Retinal fundus photograph; 50-degree field of view:
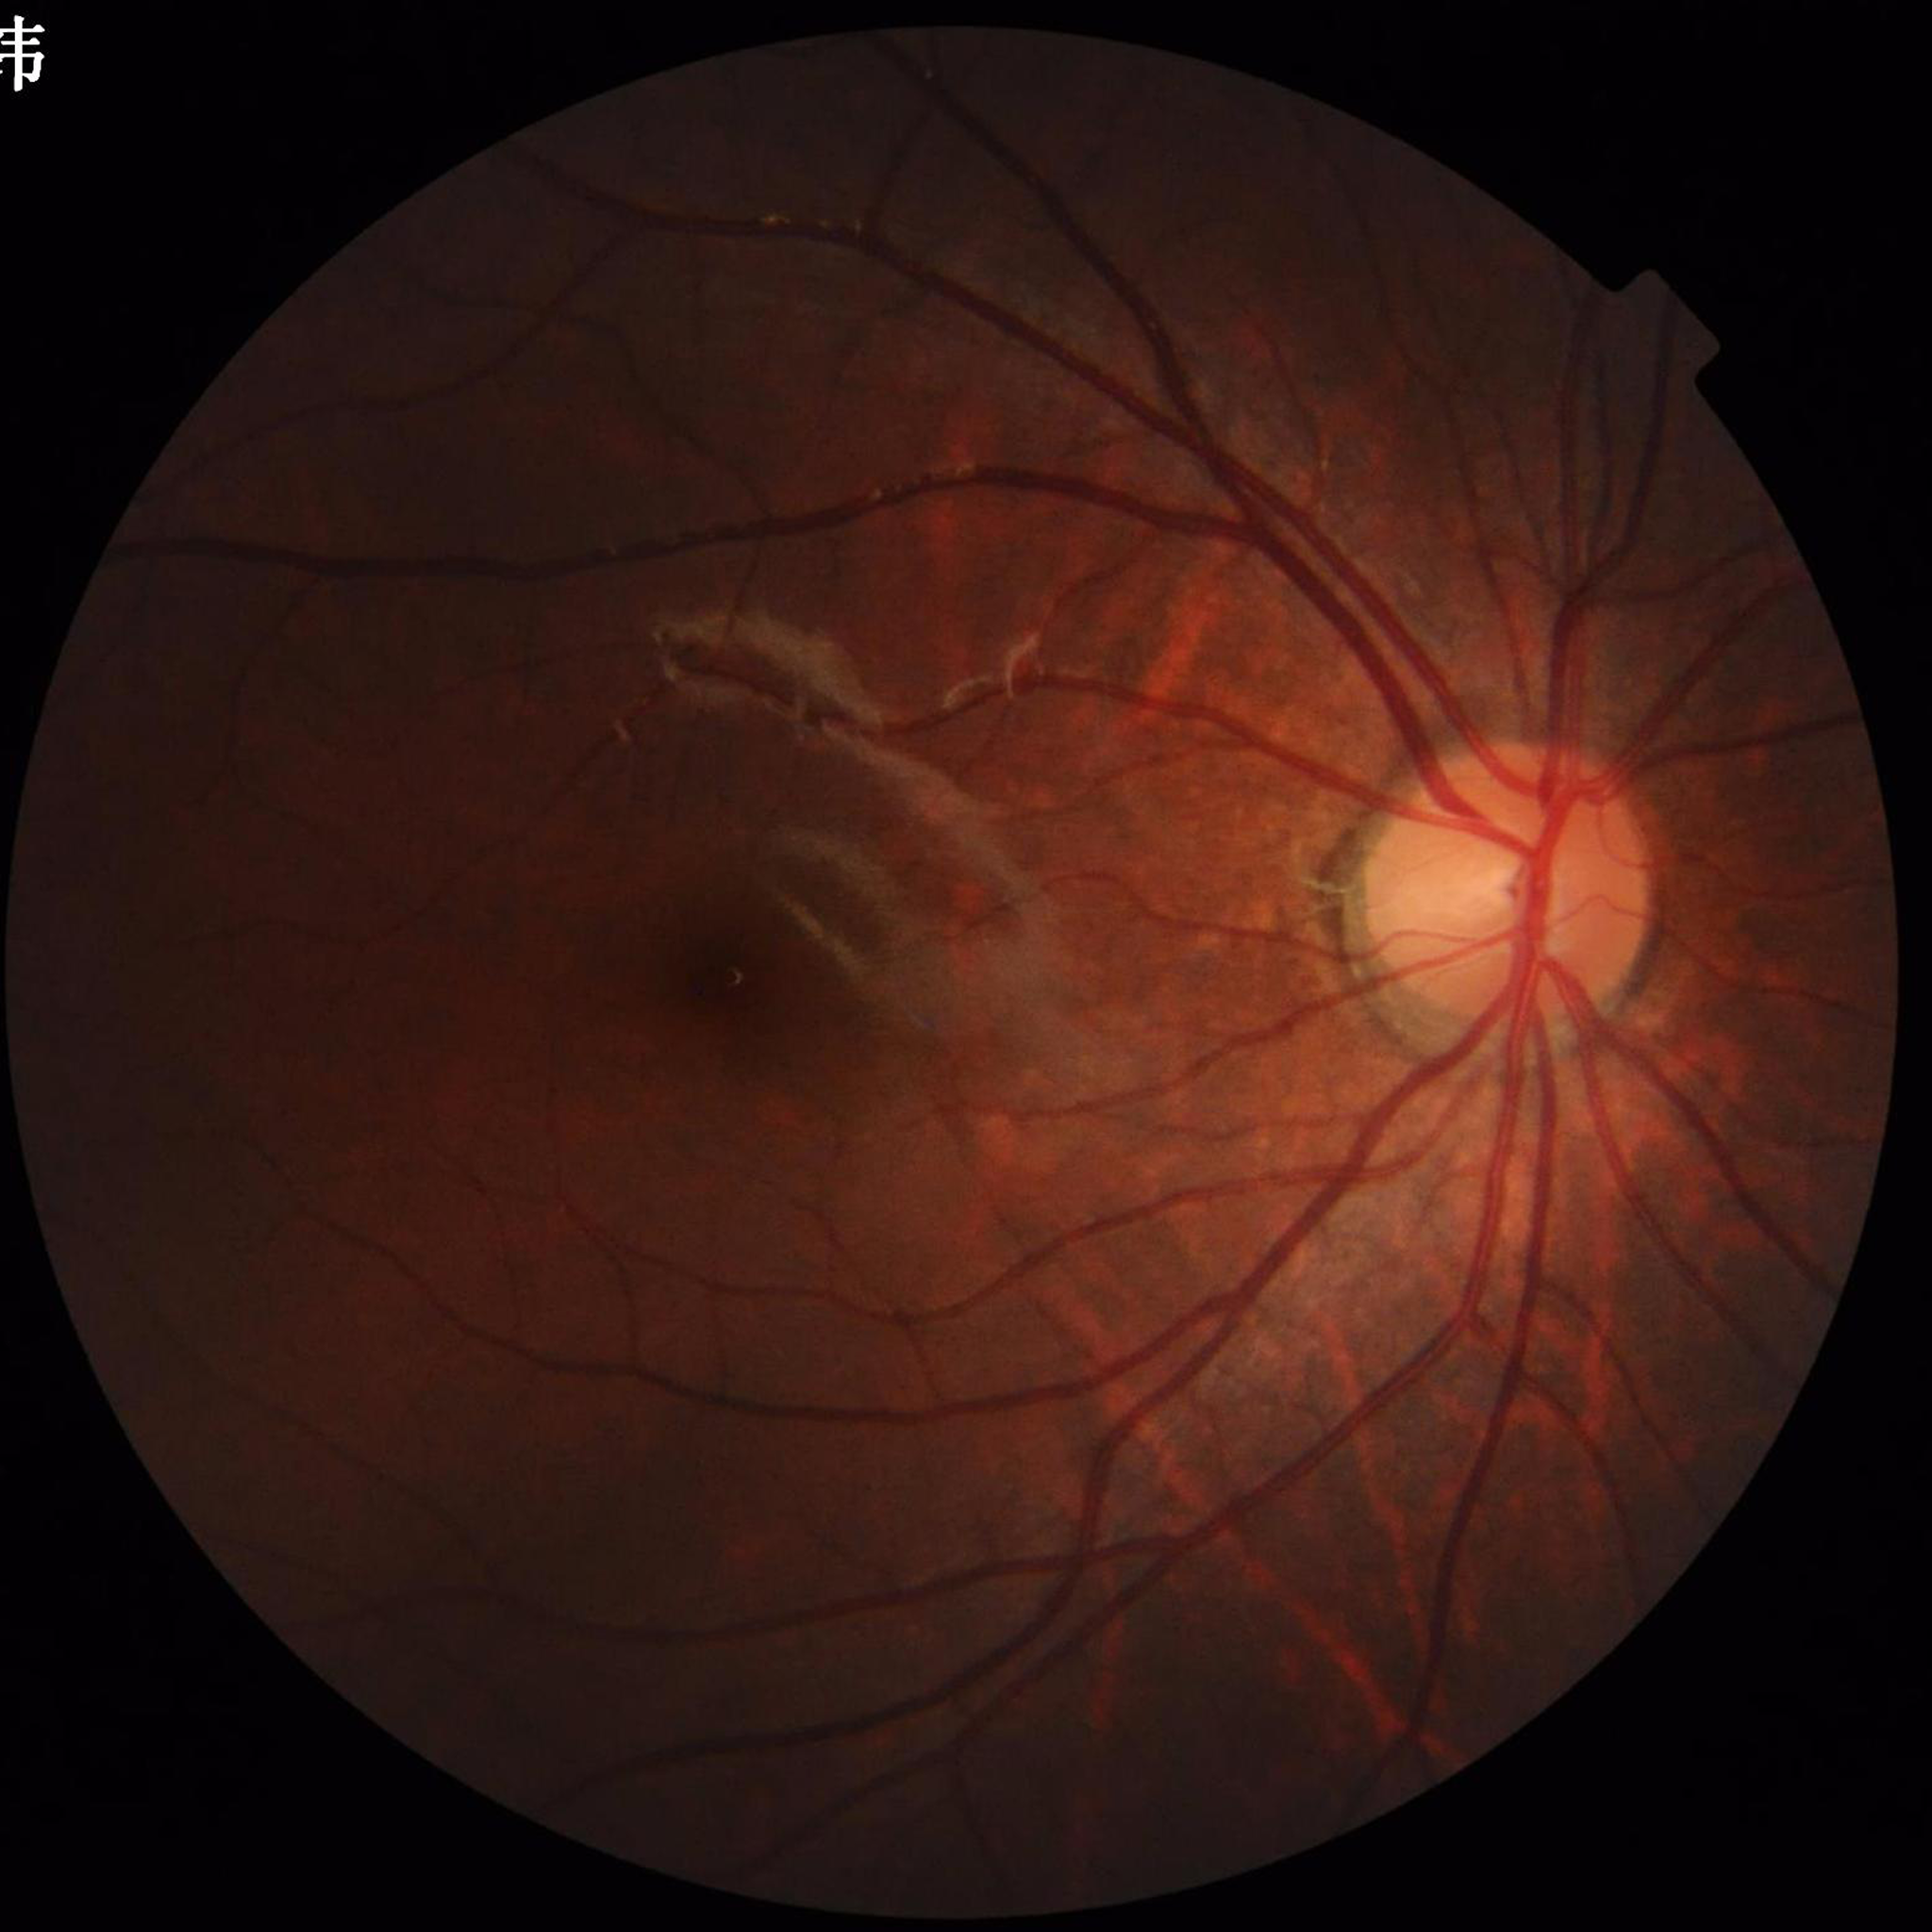

From a control without AMD, diabetic retinopathy, or glaucoma.